Retinal fundus photograph — 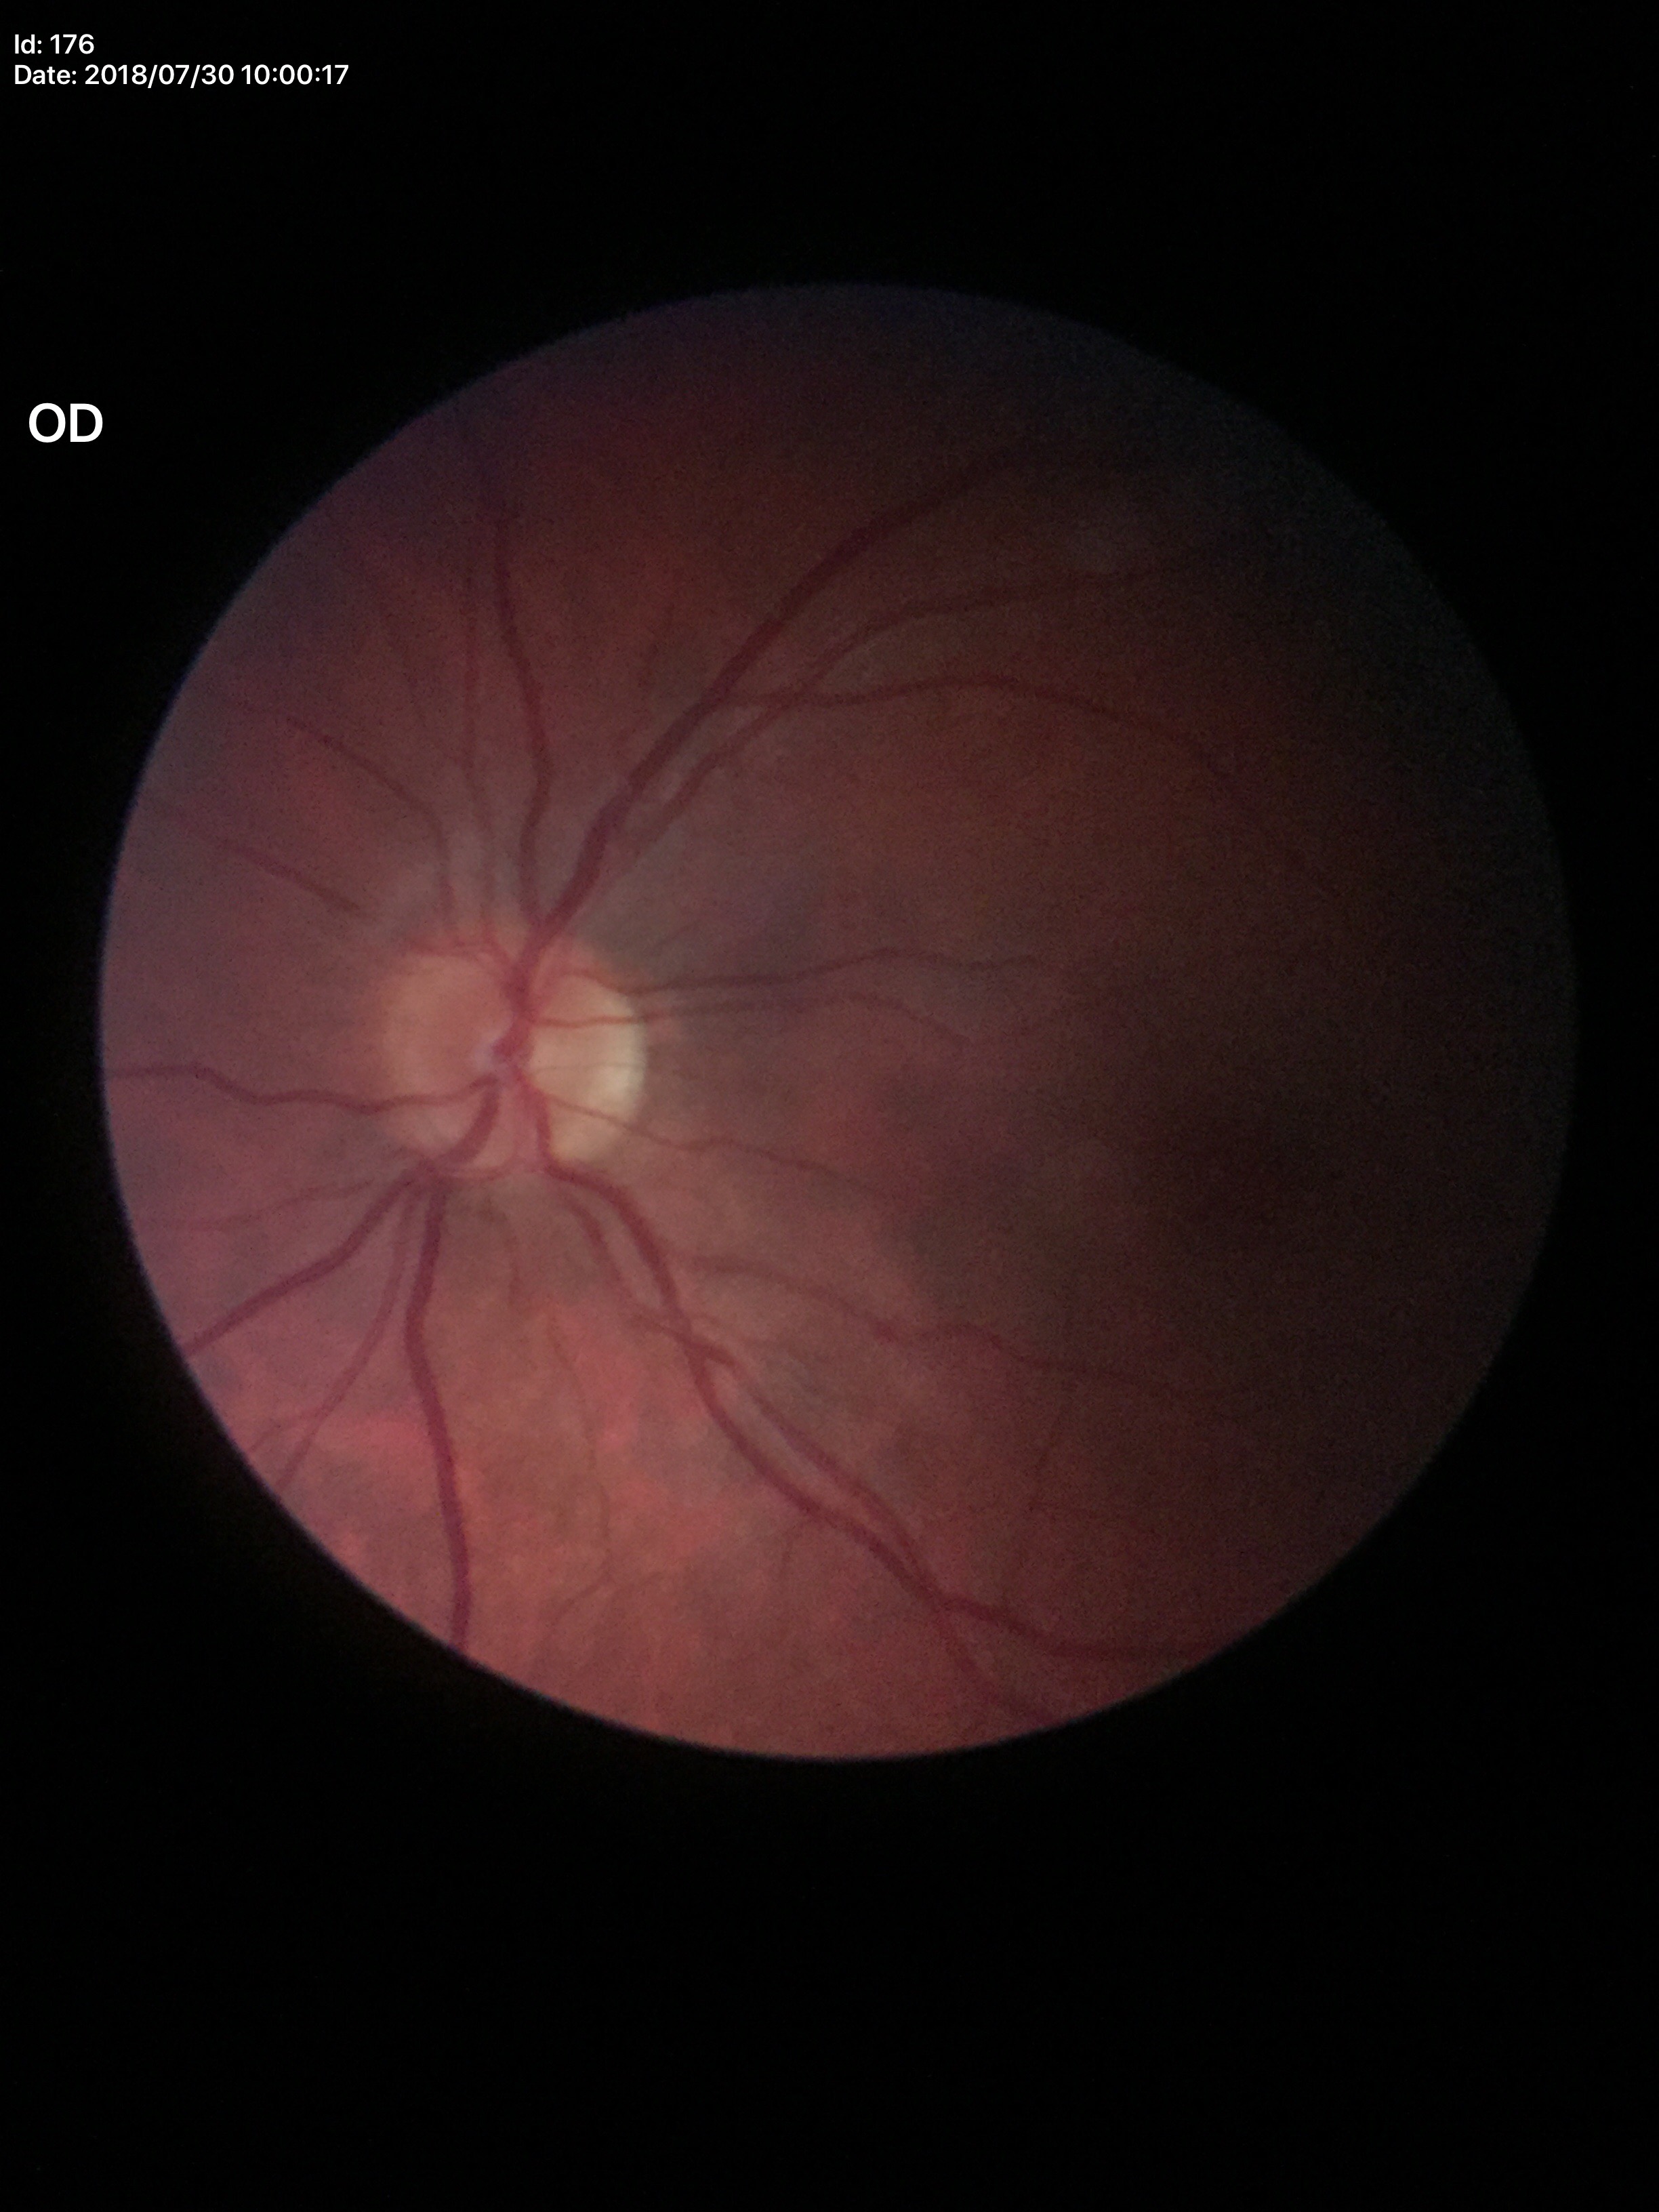
Vertical cup-to-disc ratio (VCDR) is 0.40. No evidence of glaucoma.